45° field of view. 2184x1690. Color fundus image: 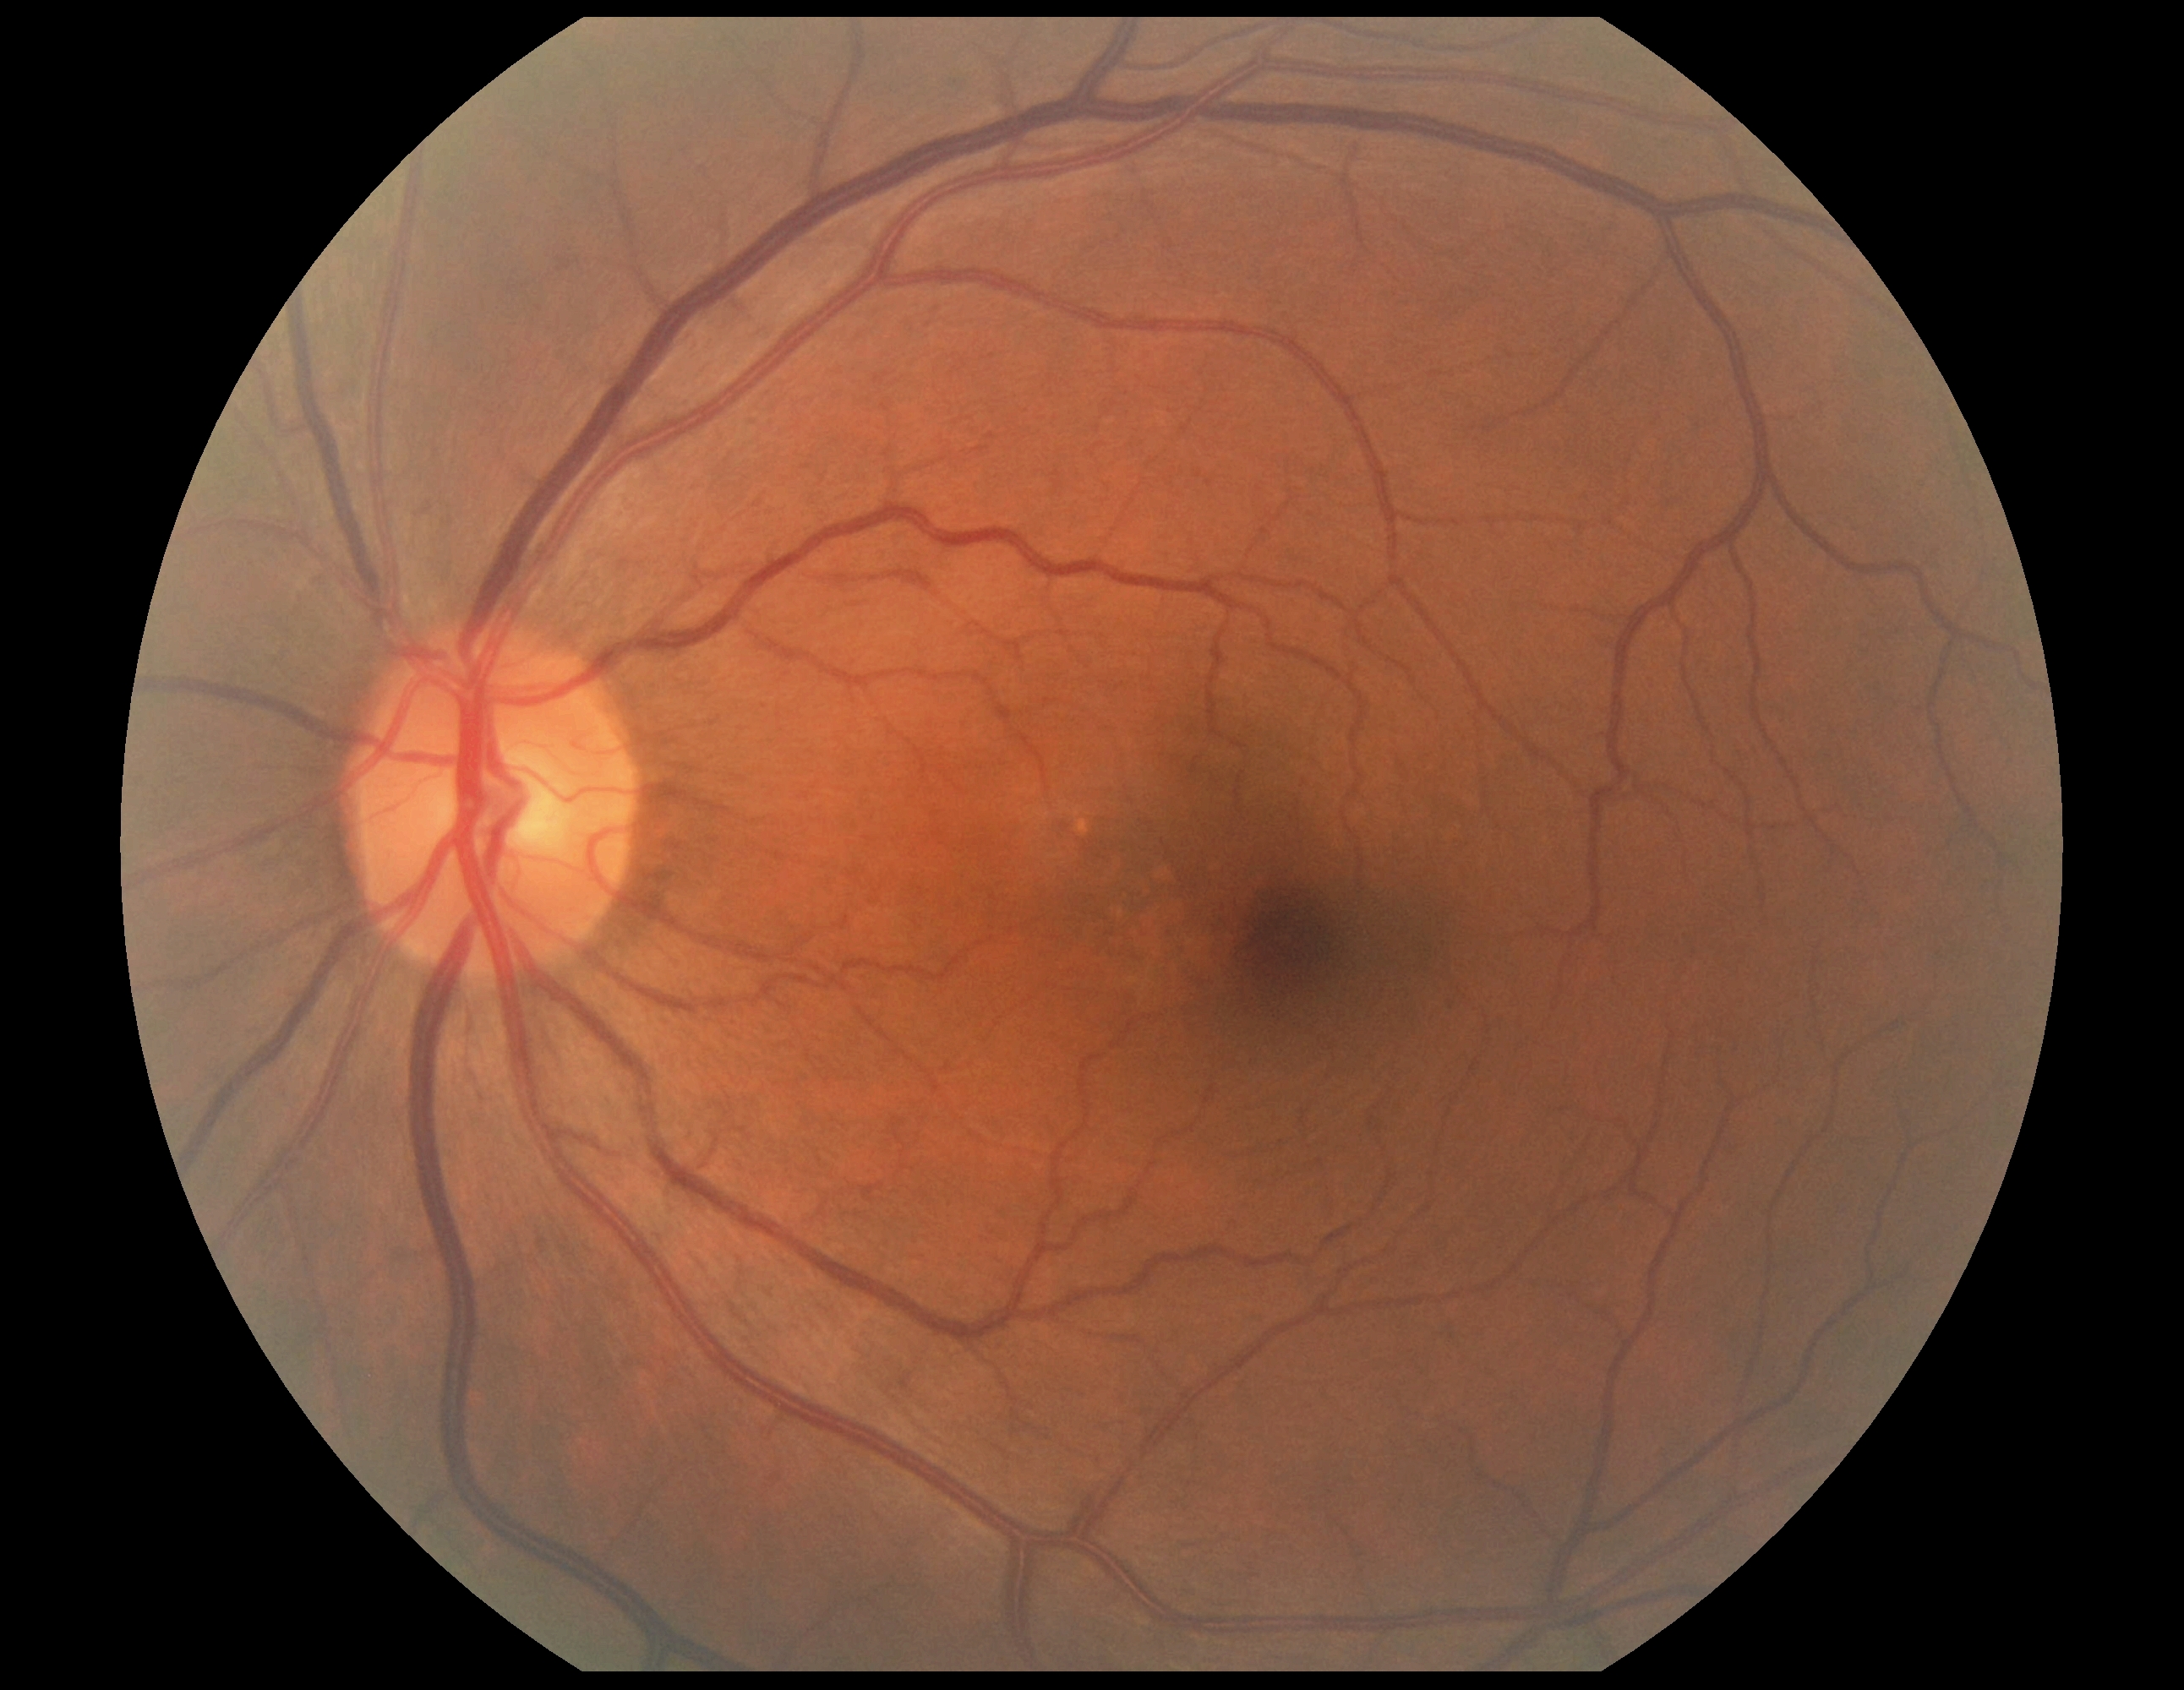 DR stage: grade 0 (no apparent retinopathy). No signs of diabetic retinopathy.